Camera: Clarity RetCam 3 (130° FOV); wide-field contact fundus photograph of an infant.
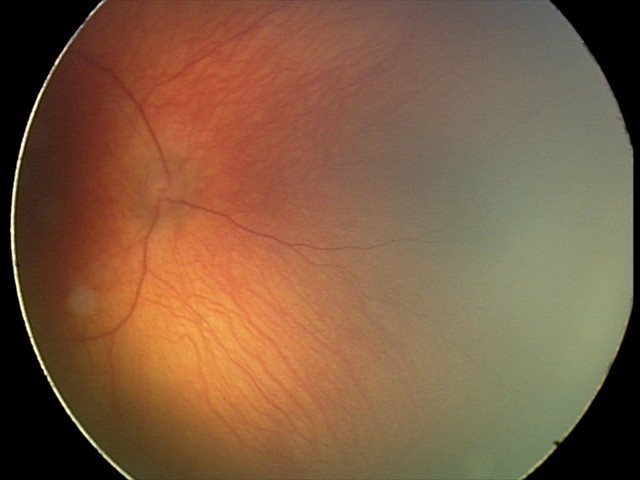 Screening examination with no abnormal retinal findings.